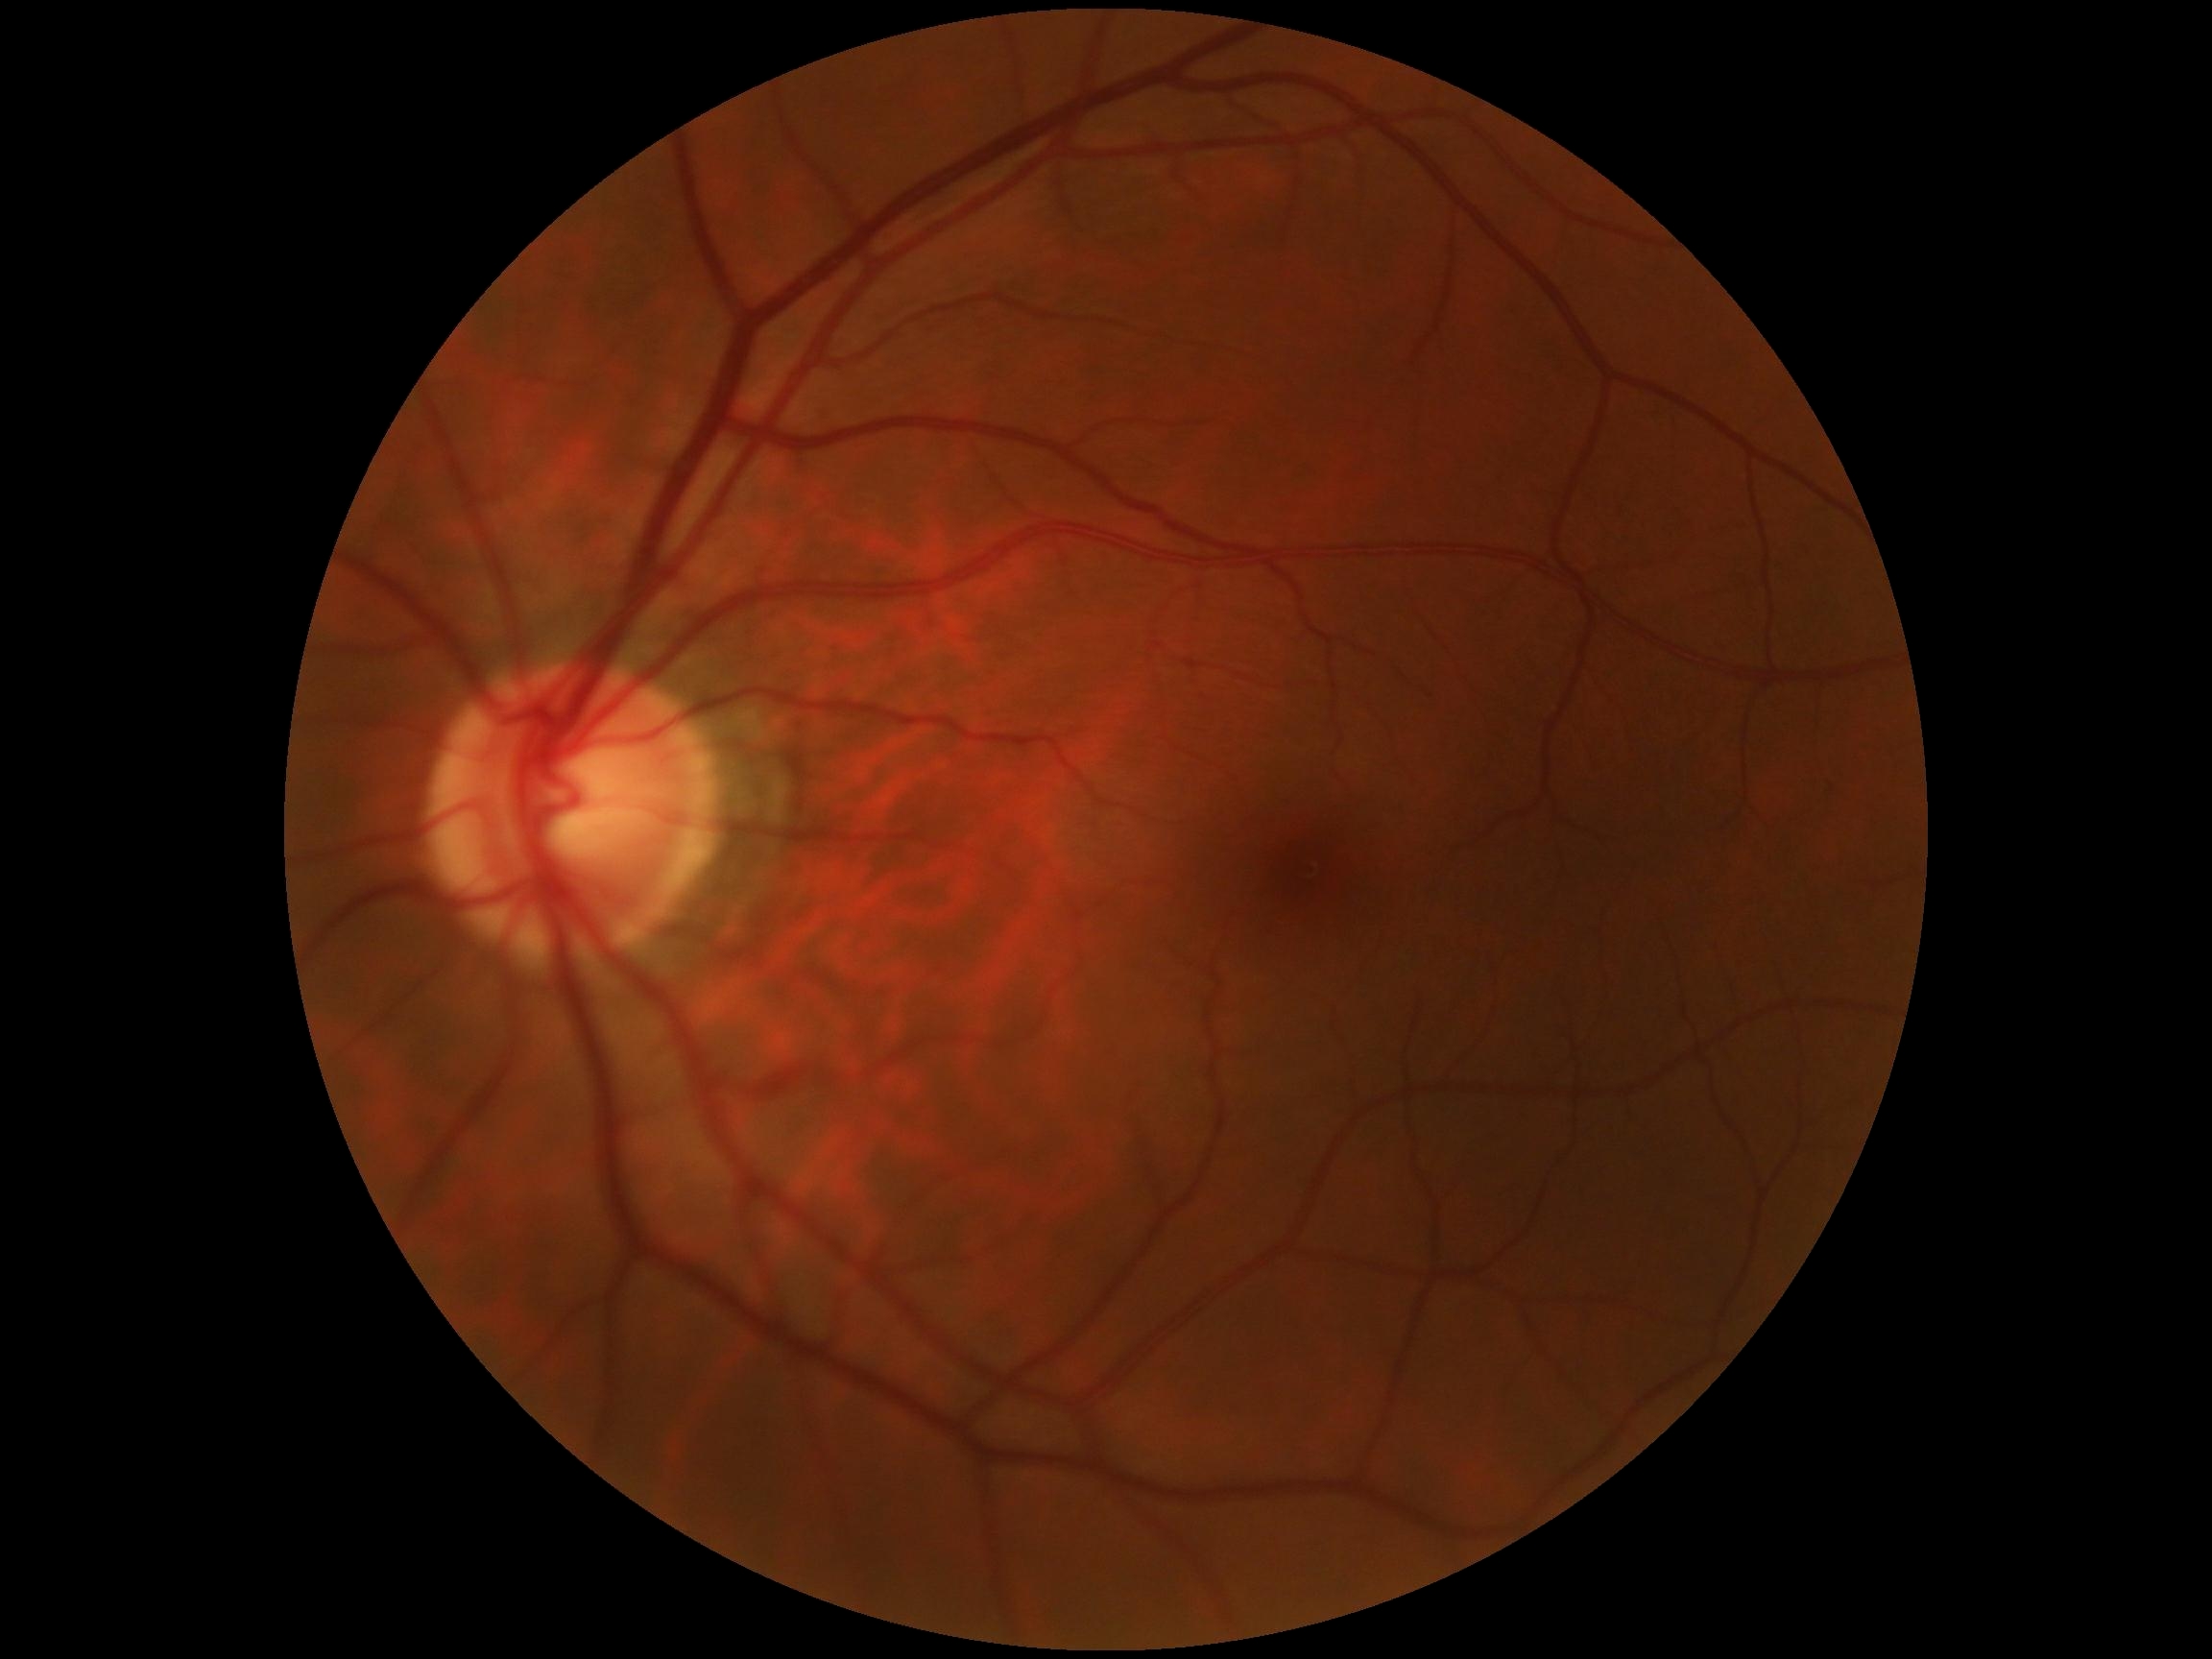 DR grade: 0 (no apparent retinopathy) — no visible signs of diabetic retinopathy.